Image size 1932x1932. Camera: Topcon TRC-NW8: 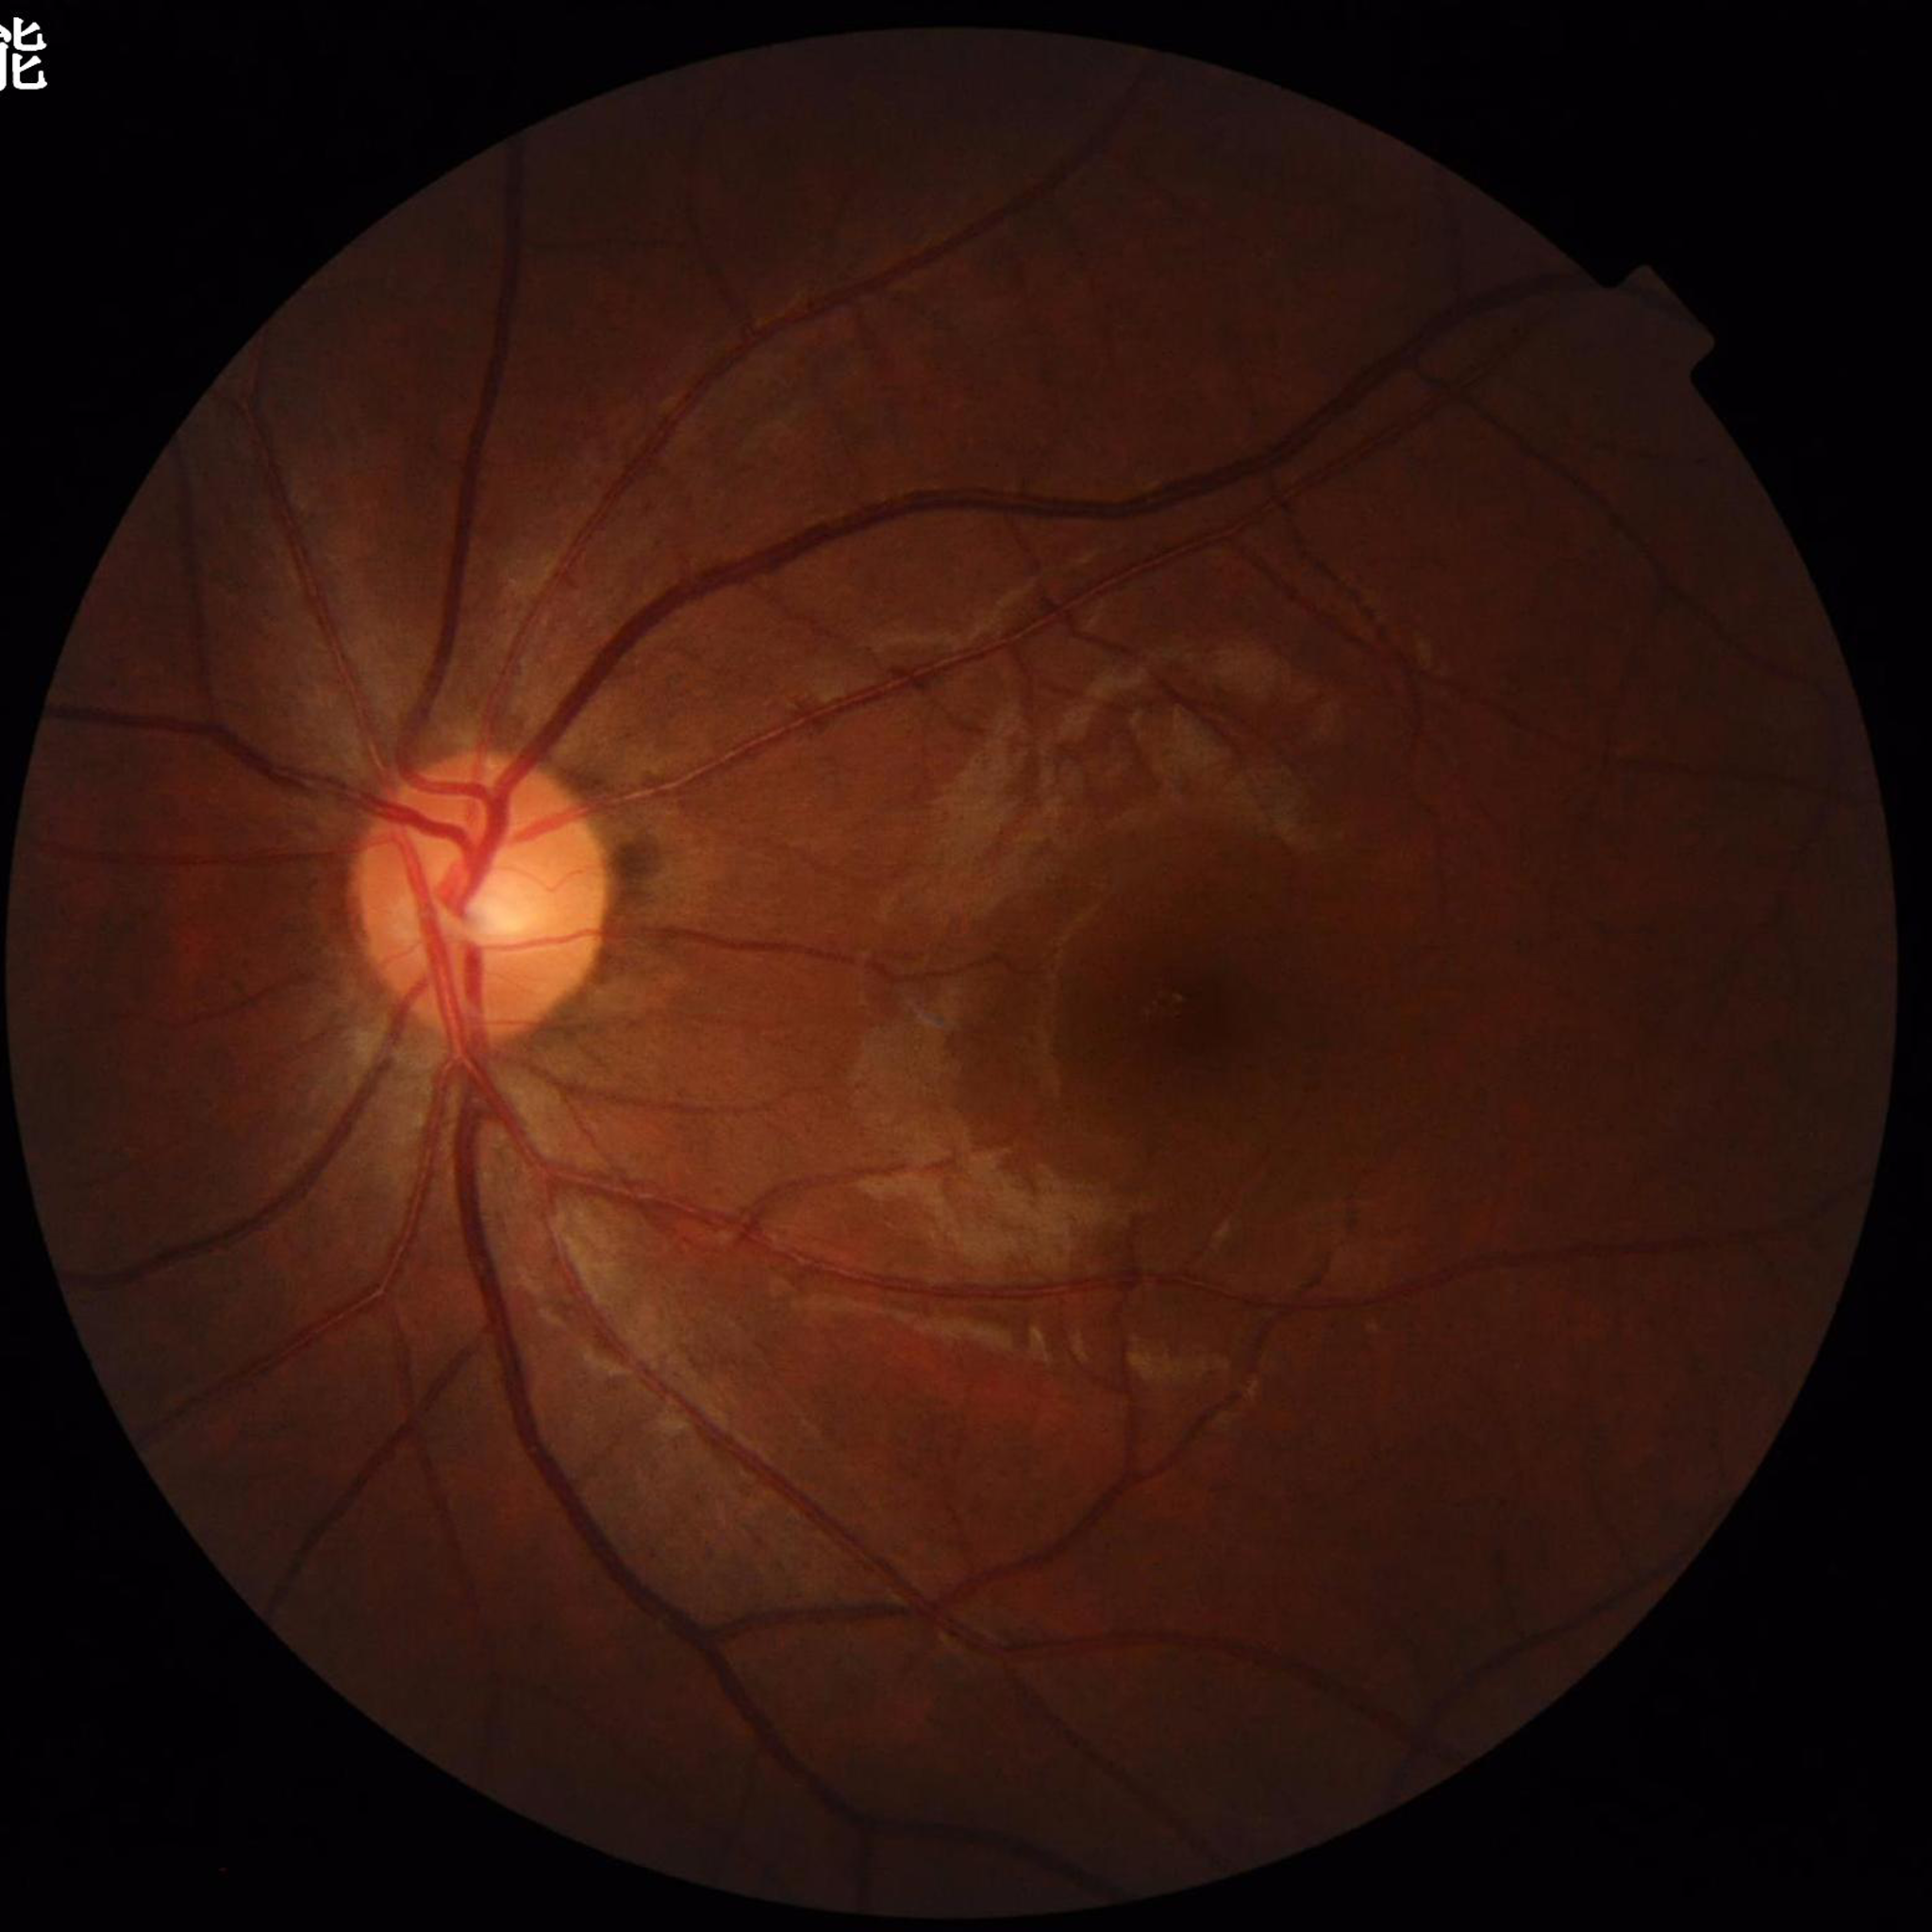
Automated quality assessment: illumination and color satisfactory, no blur, contrast adequate.
Fundus image of an eye with glaucoma.